45° field of view · 2212 by 1659 pixels · color fundus photograph:
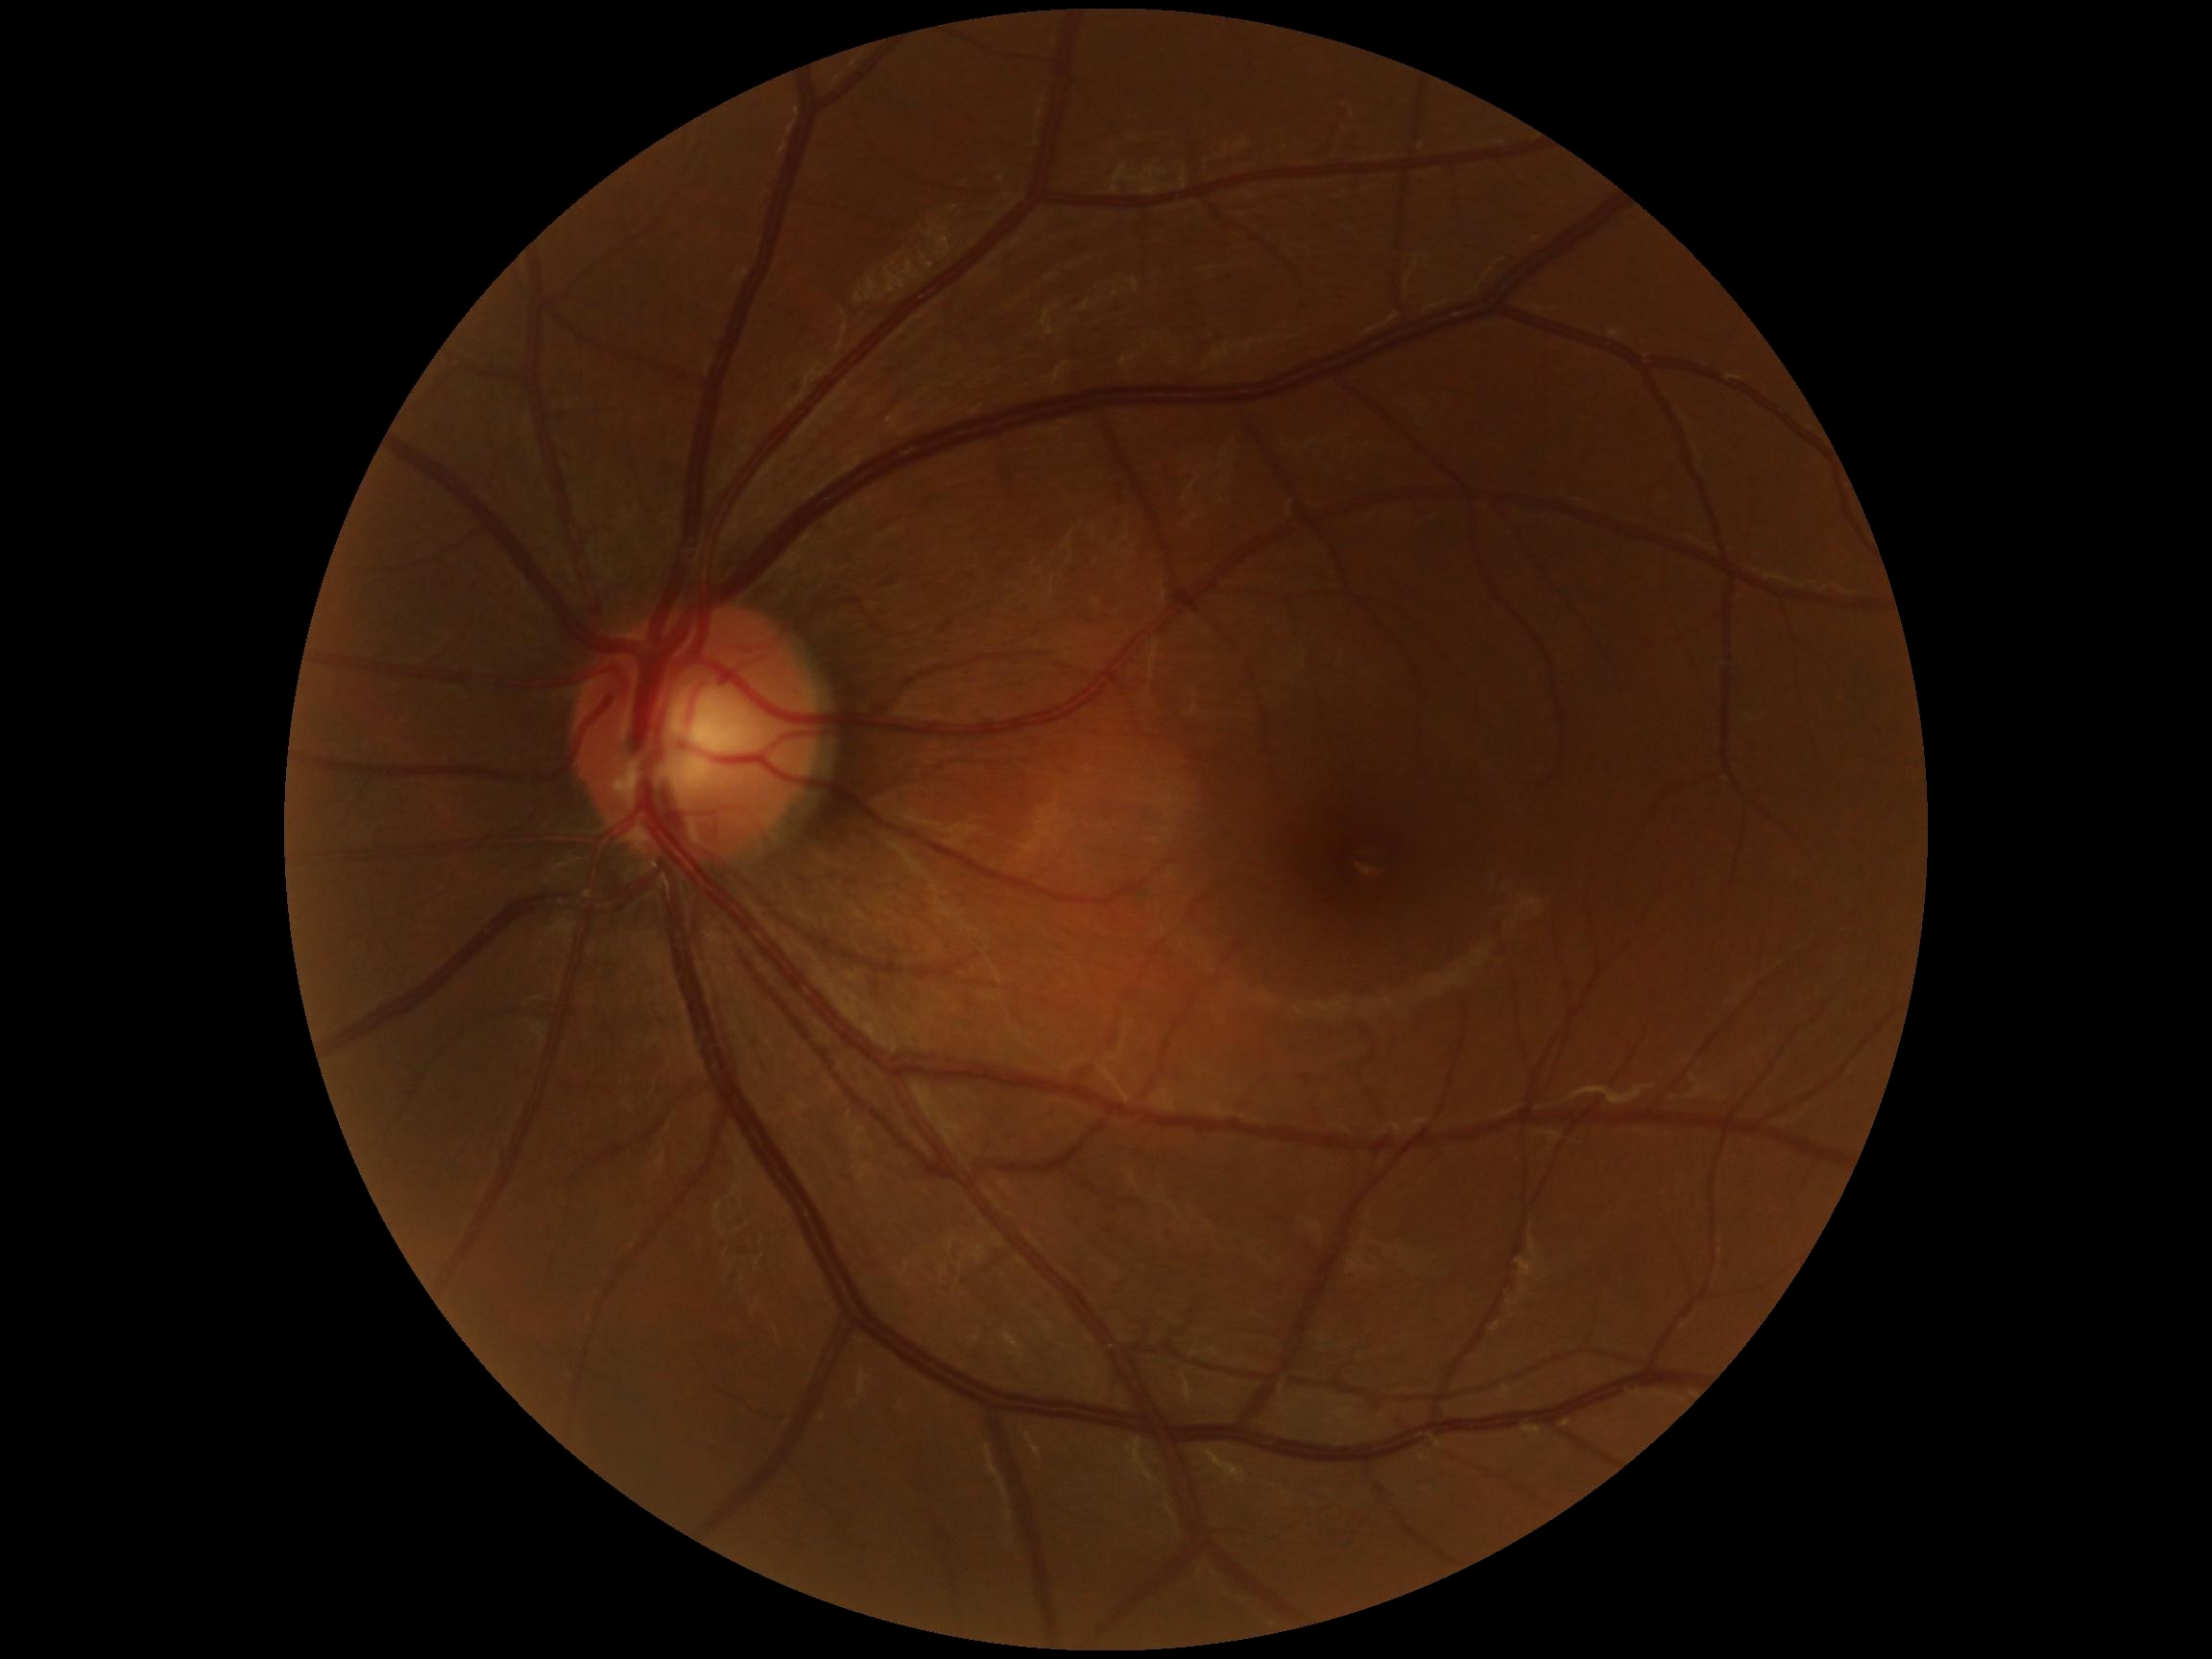 DR: 0/4 — no visible signs of diabetic retinopathy. No diabetic retinal disease findings.